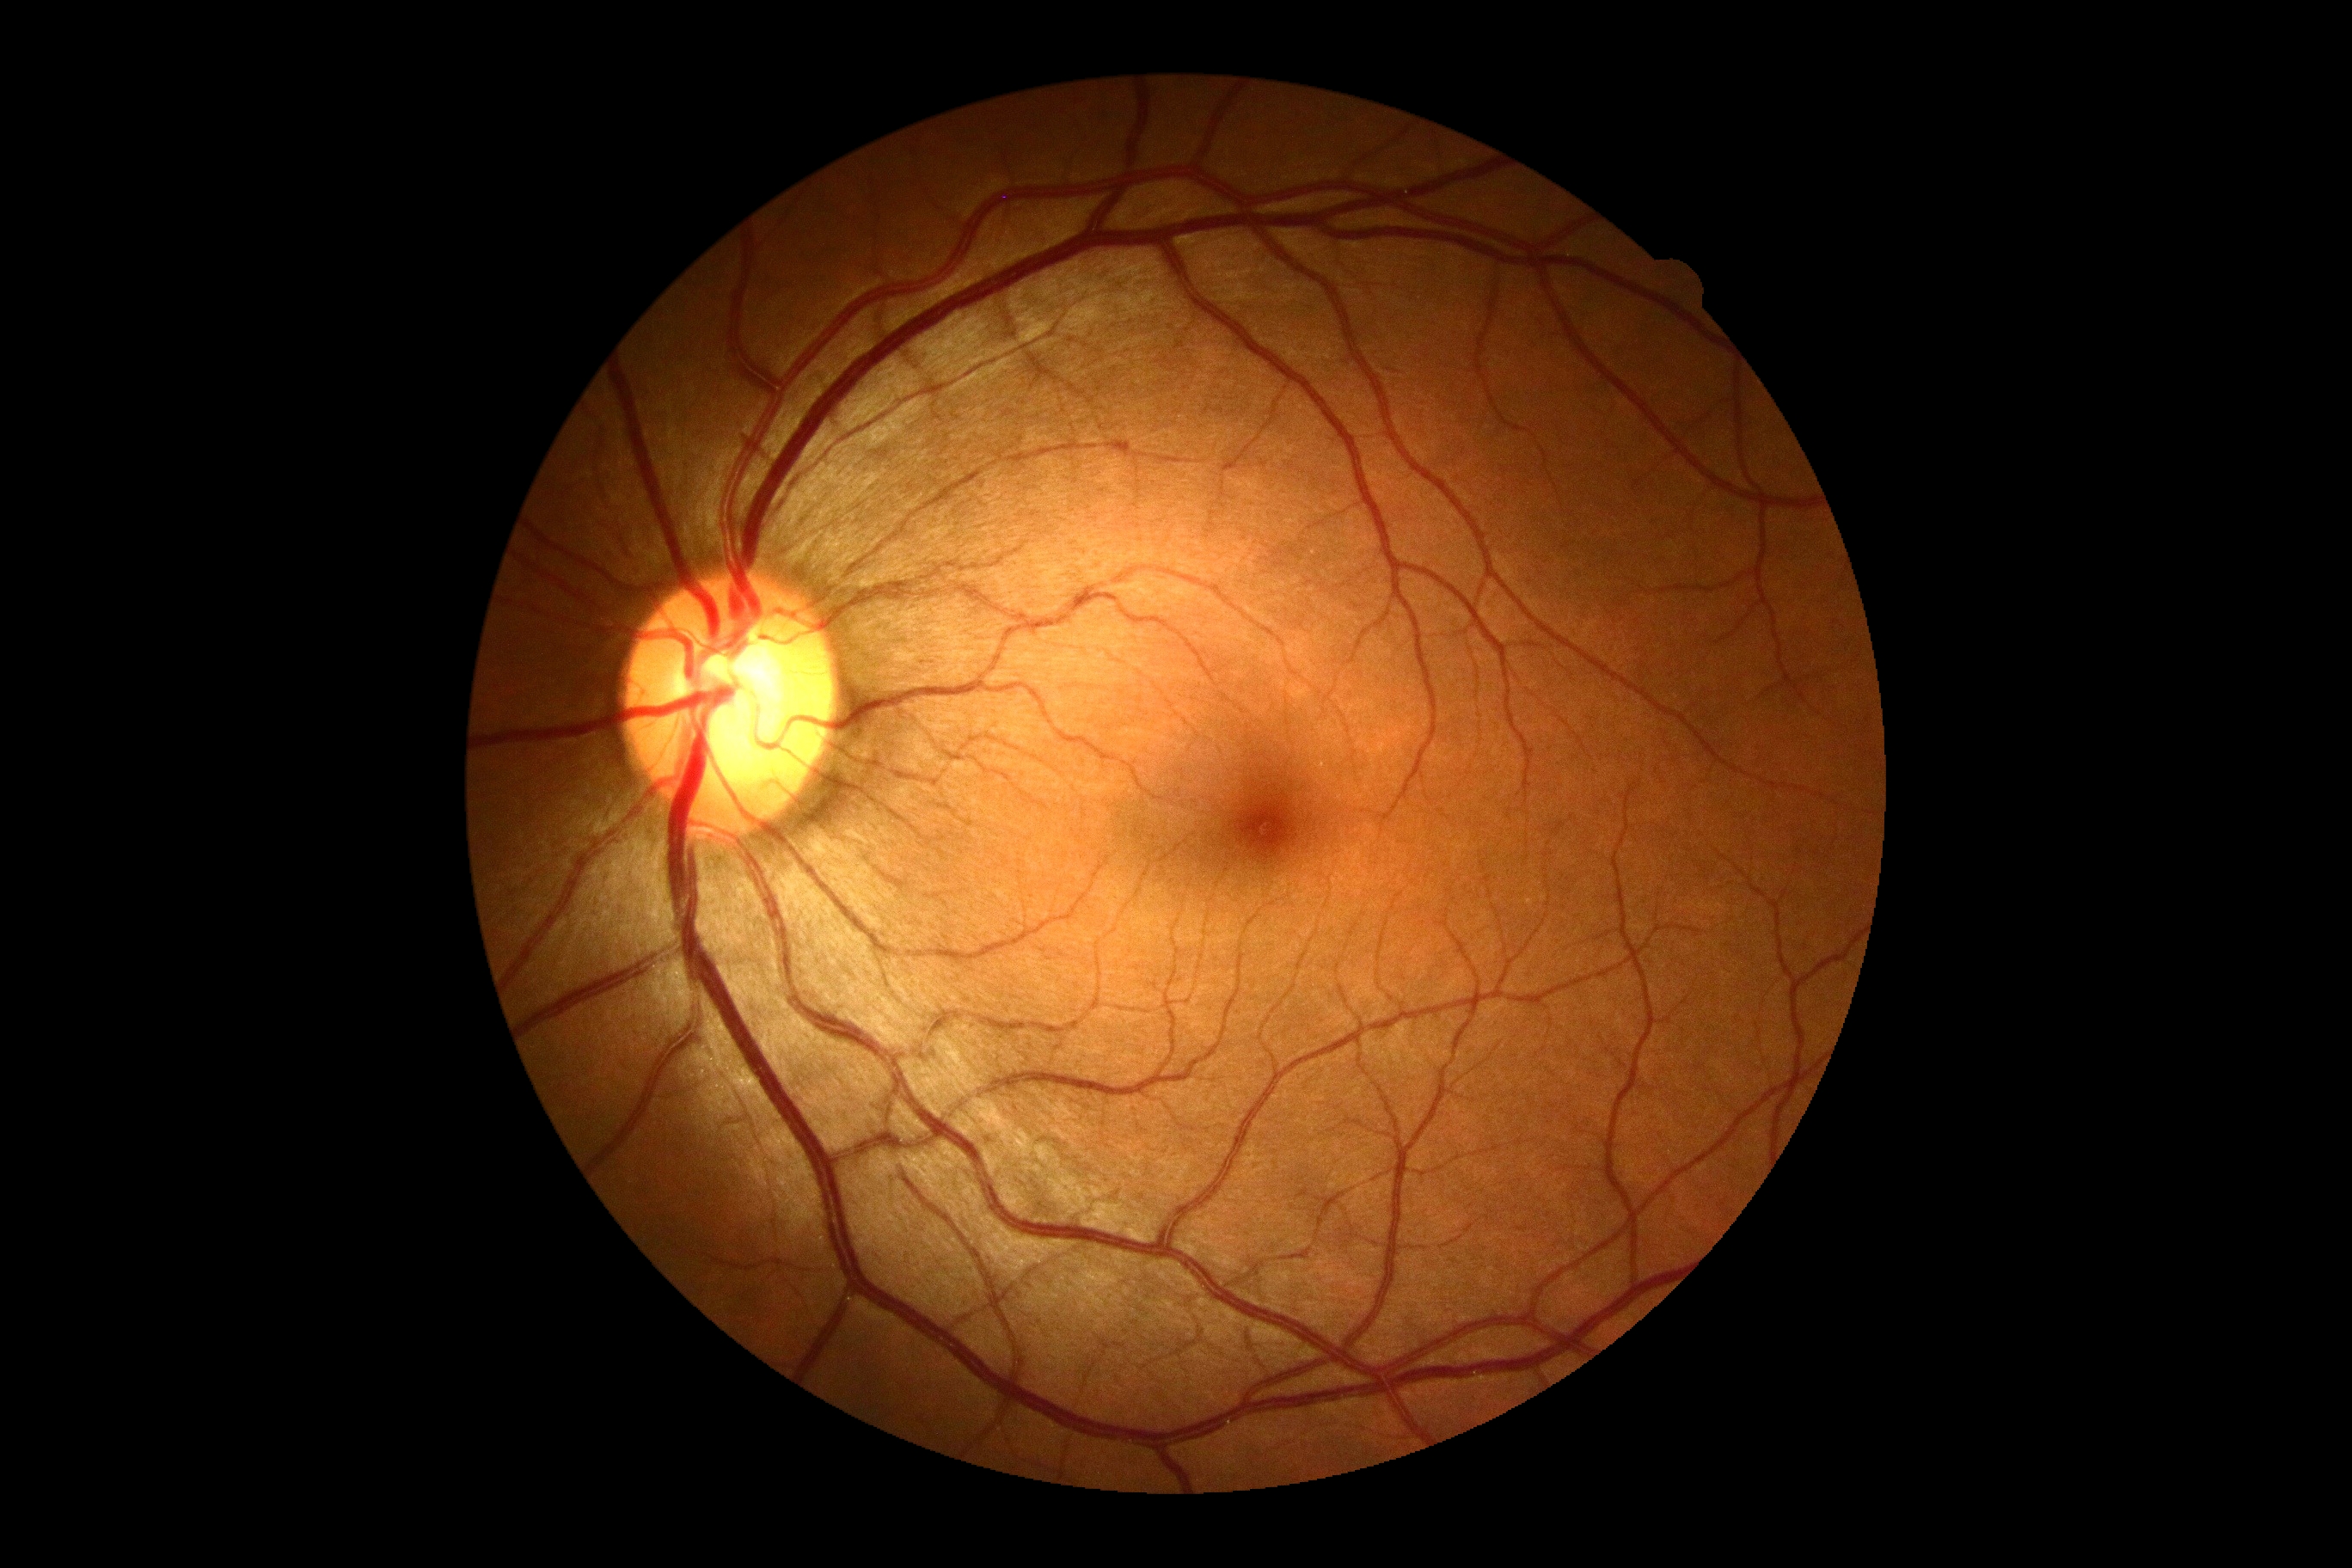 Retinopathy: 0.